CFP; 2352 by 1568 pixels; FOV: 45 degrees.
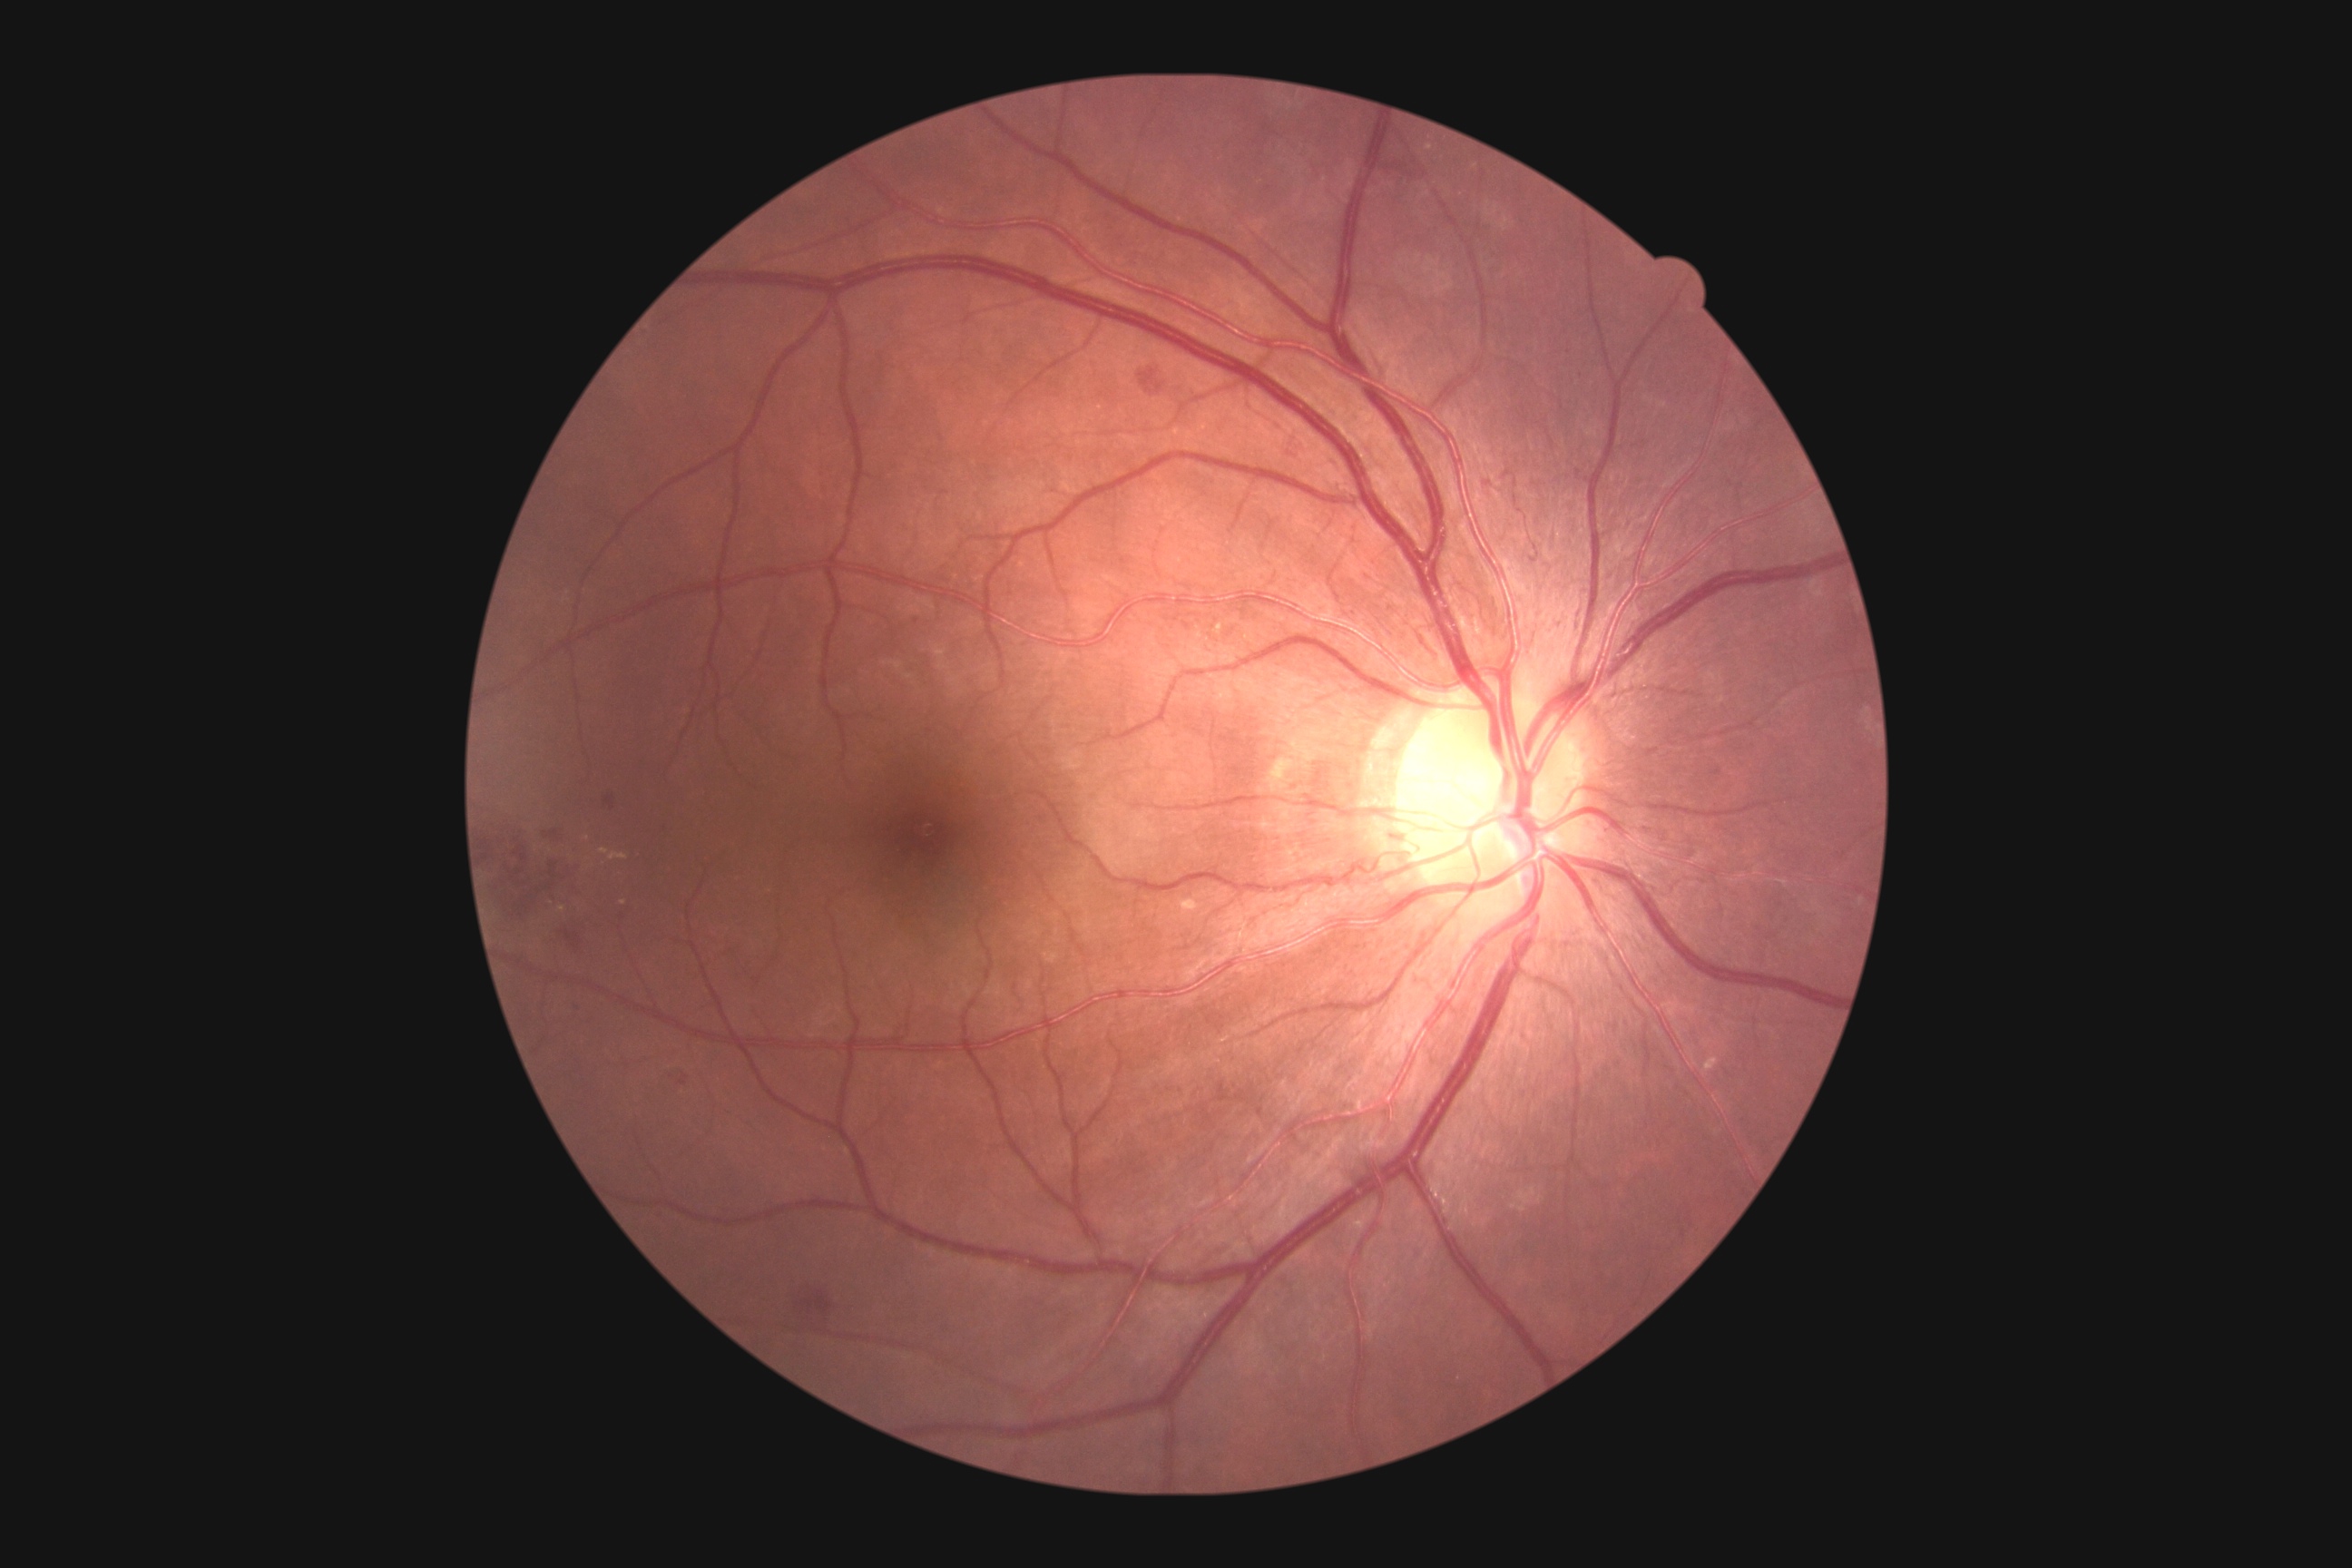 Findings:
- DR class — non-proliferative diabetic retinopathy
- diabetic retinopathy — 2 — more than just microaneurysms but less than severe NPDR